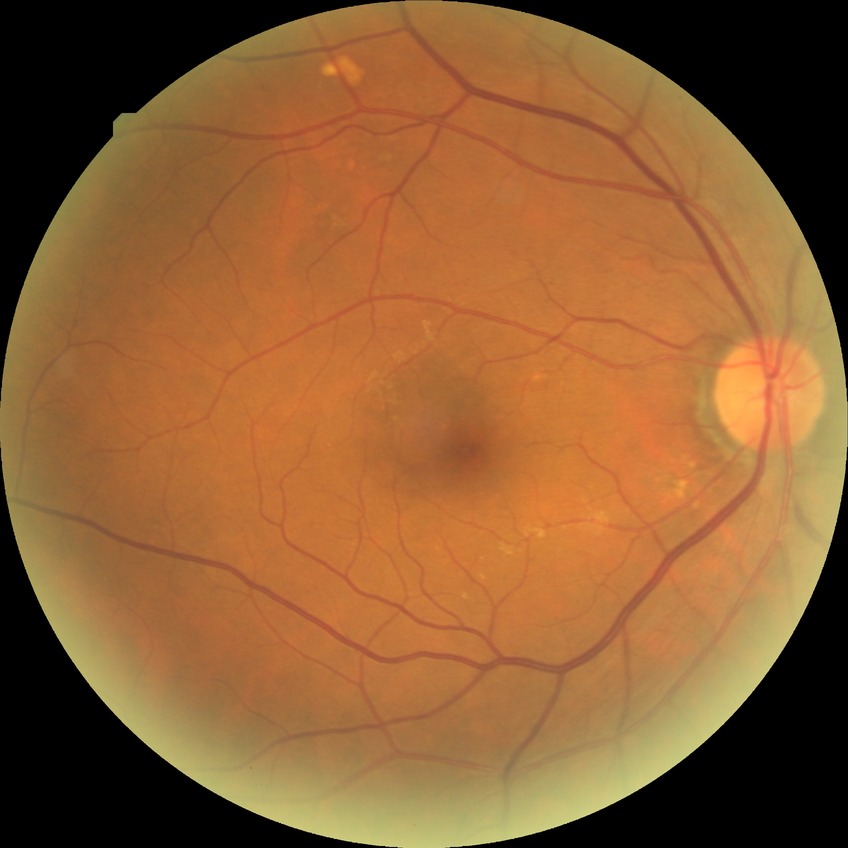

diabetic retinopathy grade: no diabetic retinopathy.